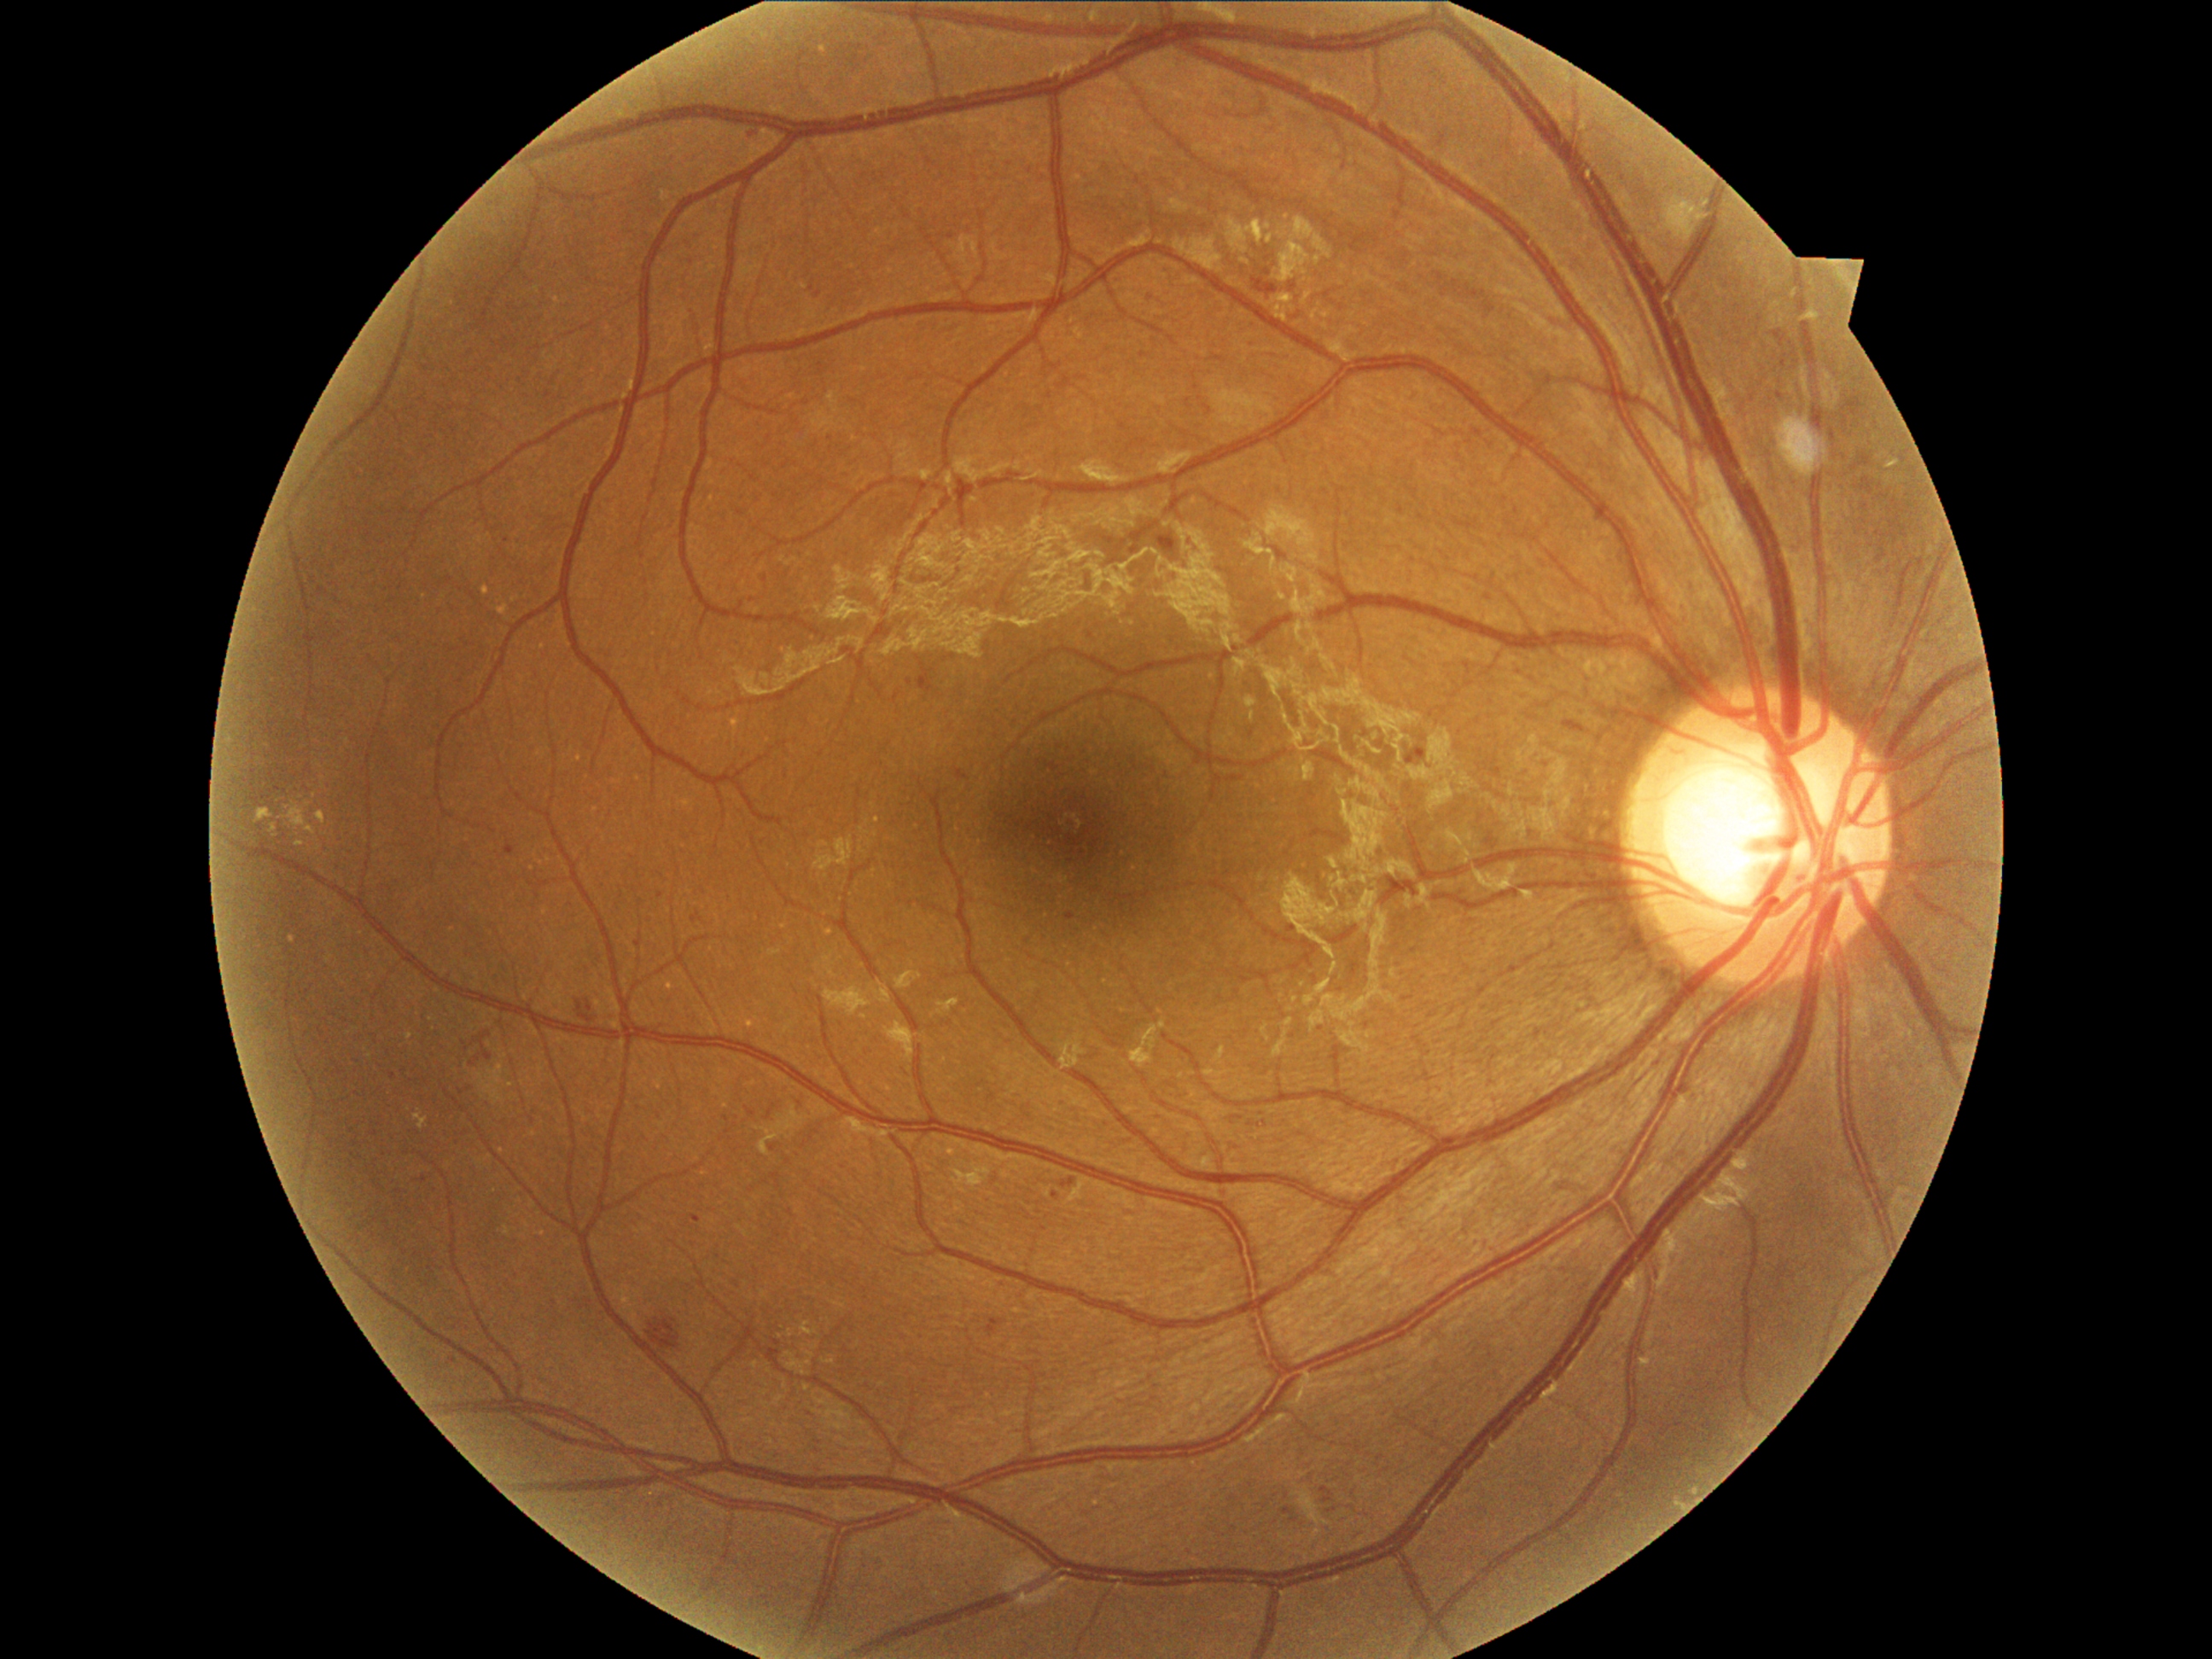 Diabetic retinopathy severity is moderate NPDR (grade 2).